Color fundus photograph. 848x848:
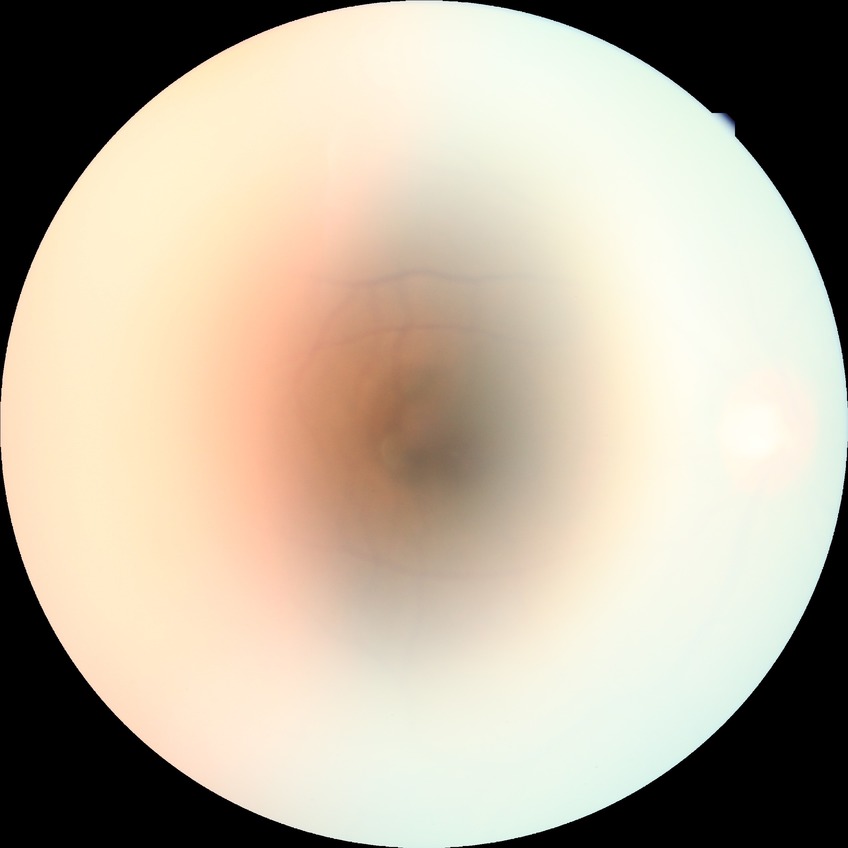 Diabetic retinopathy (DR) is simple diabetic retinopathy (SDR).